CFP
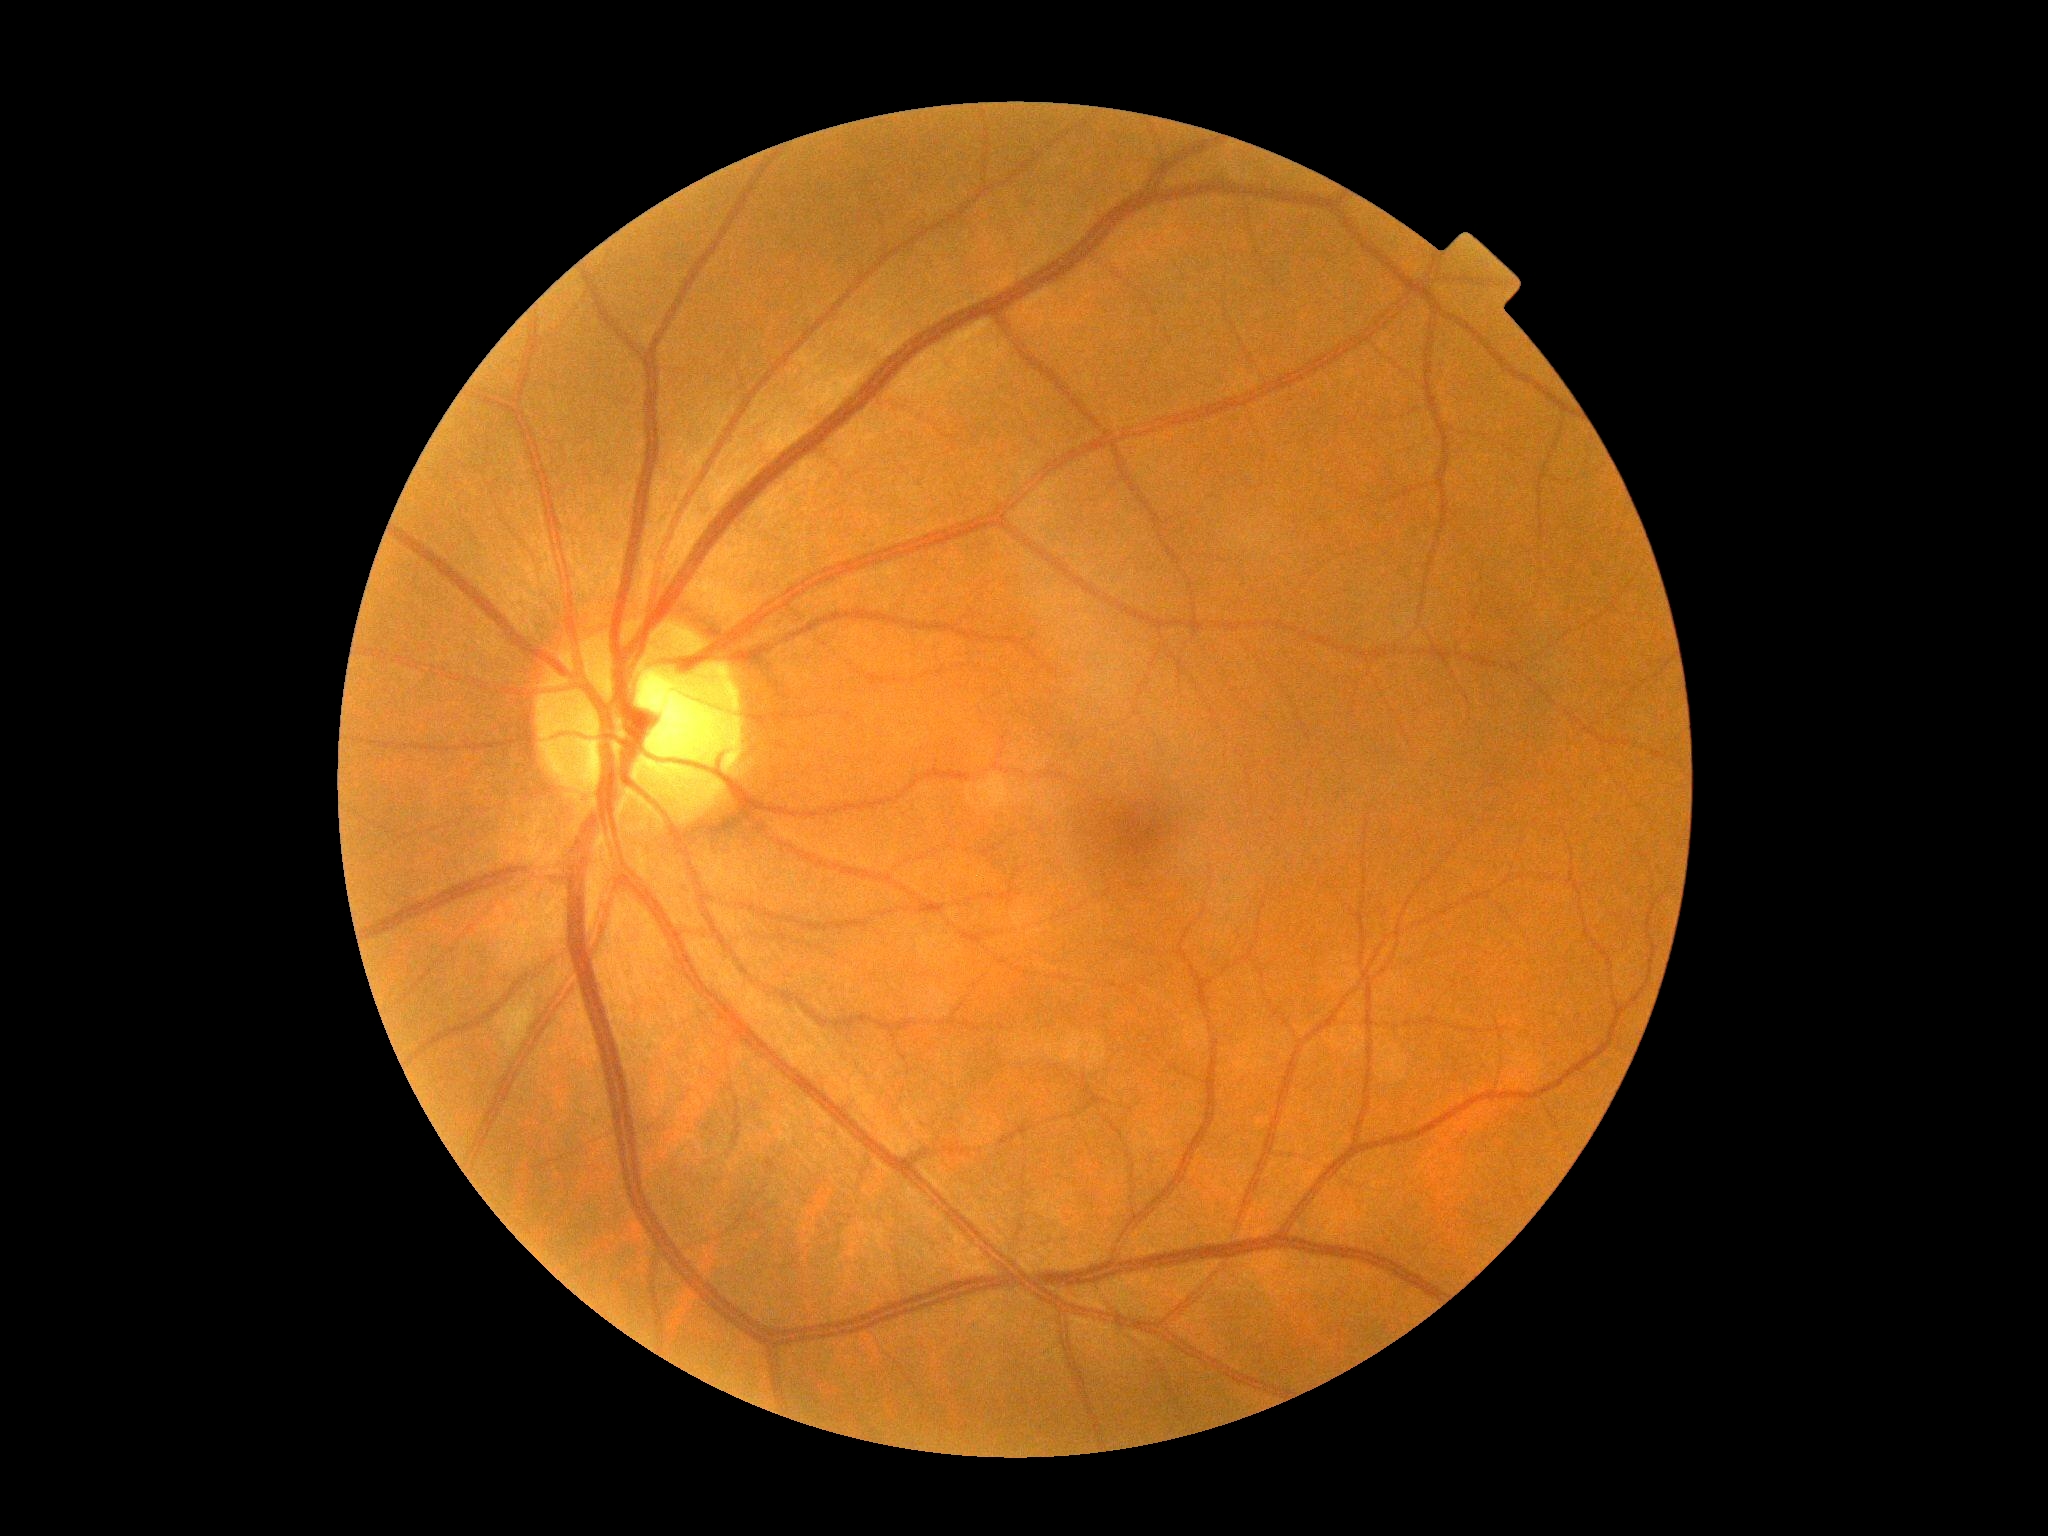 Retinopathy: no apparent retinopathy (grade 0).